Wide-field fundus photograph from neonatal ROP screening. Captured with the Phoenix ICON (100° field of view): 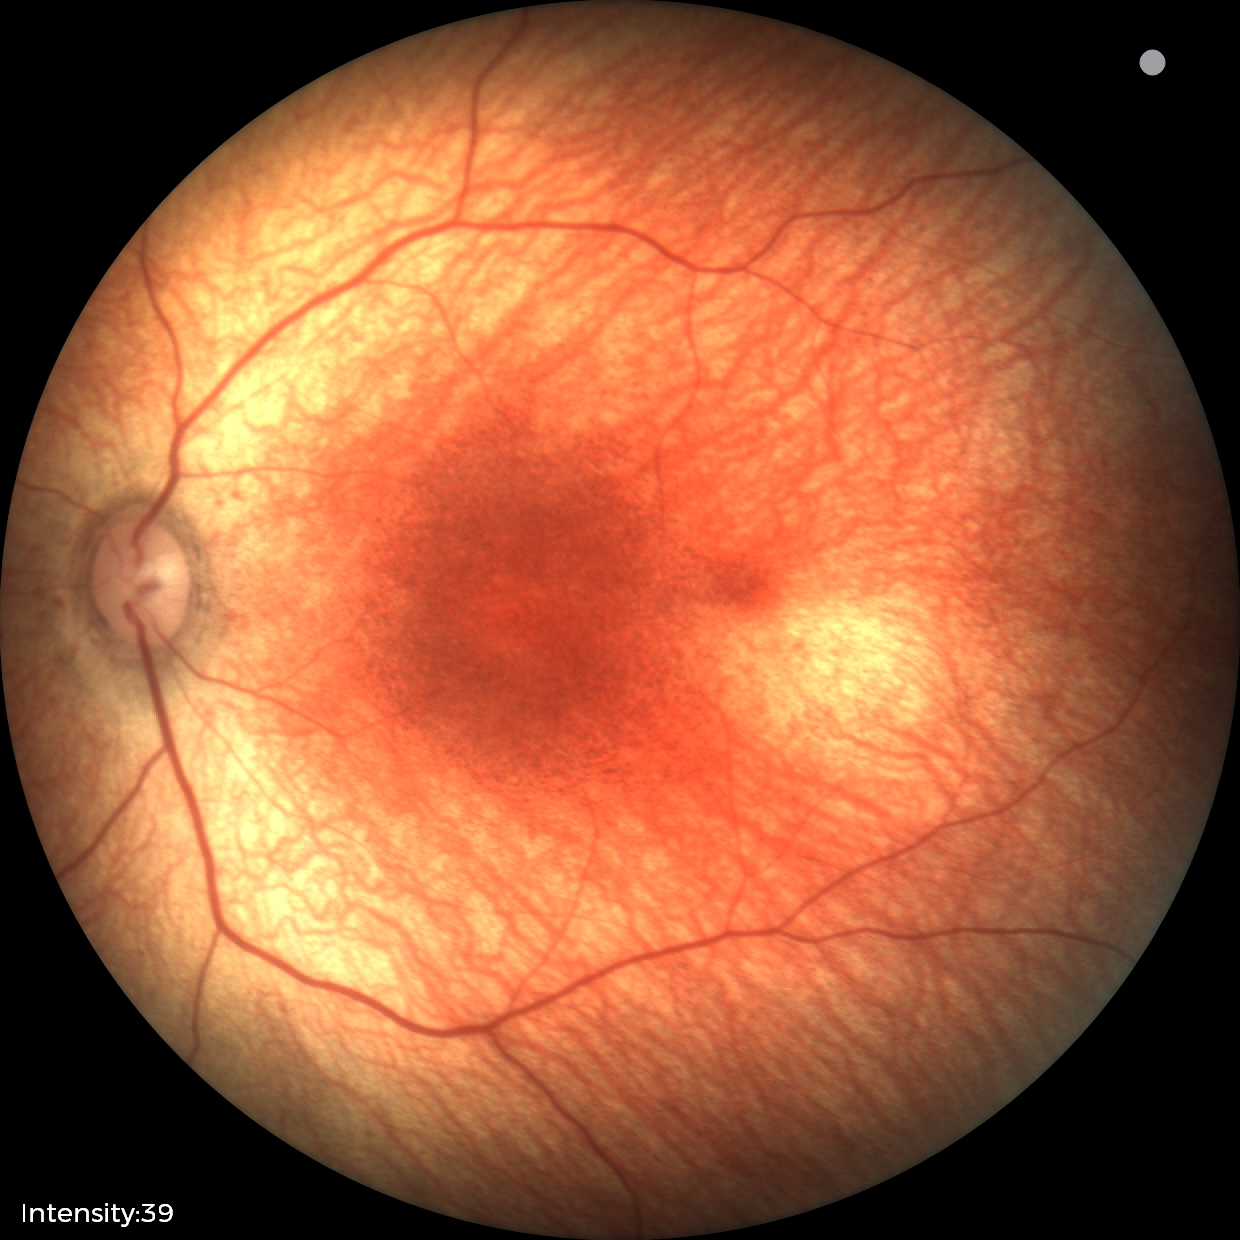

Physiological retinal appearance for postconceptual age.